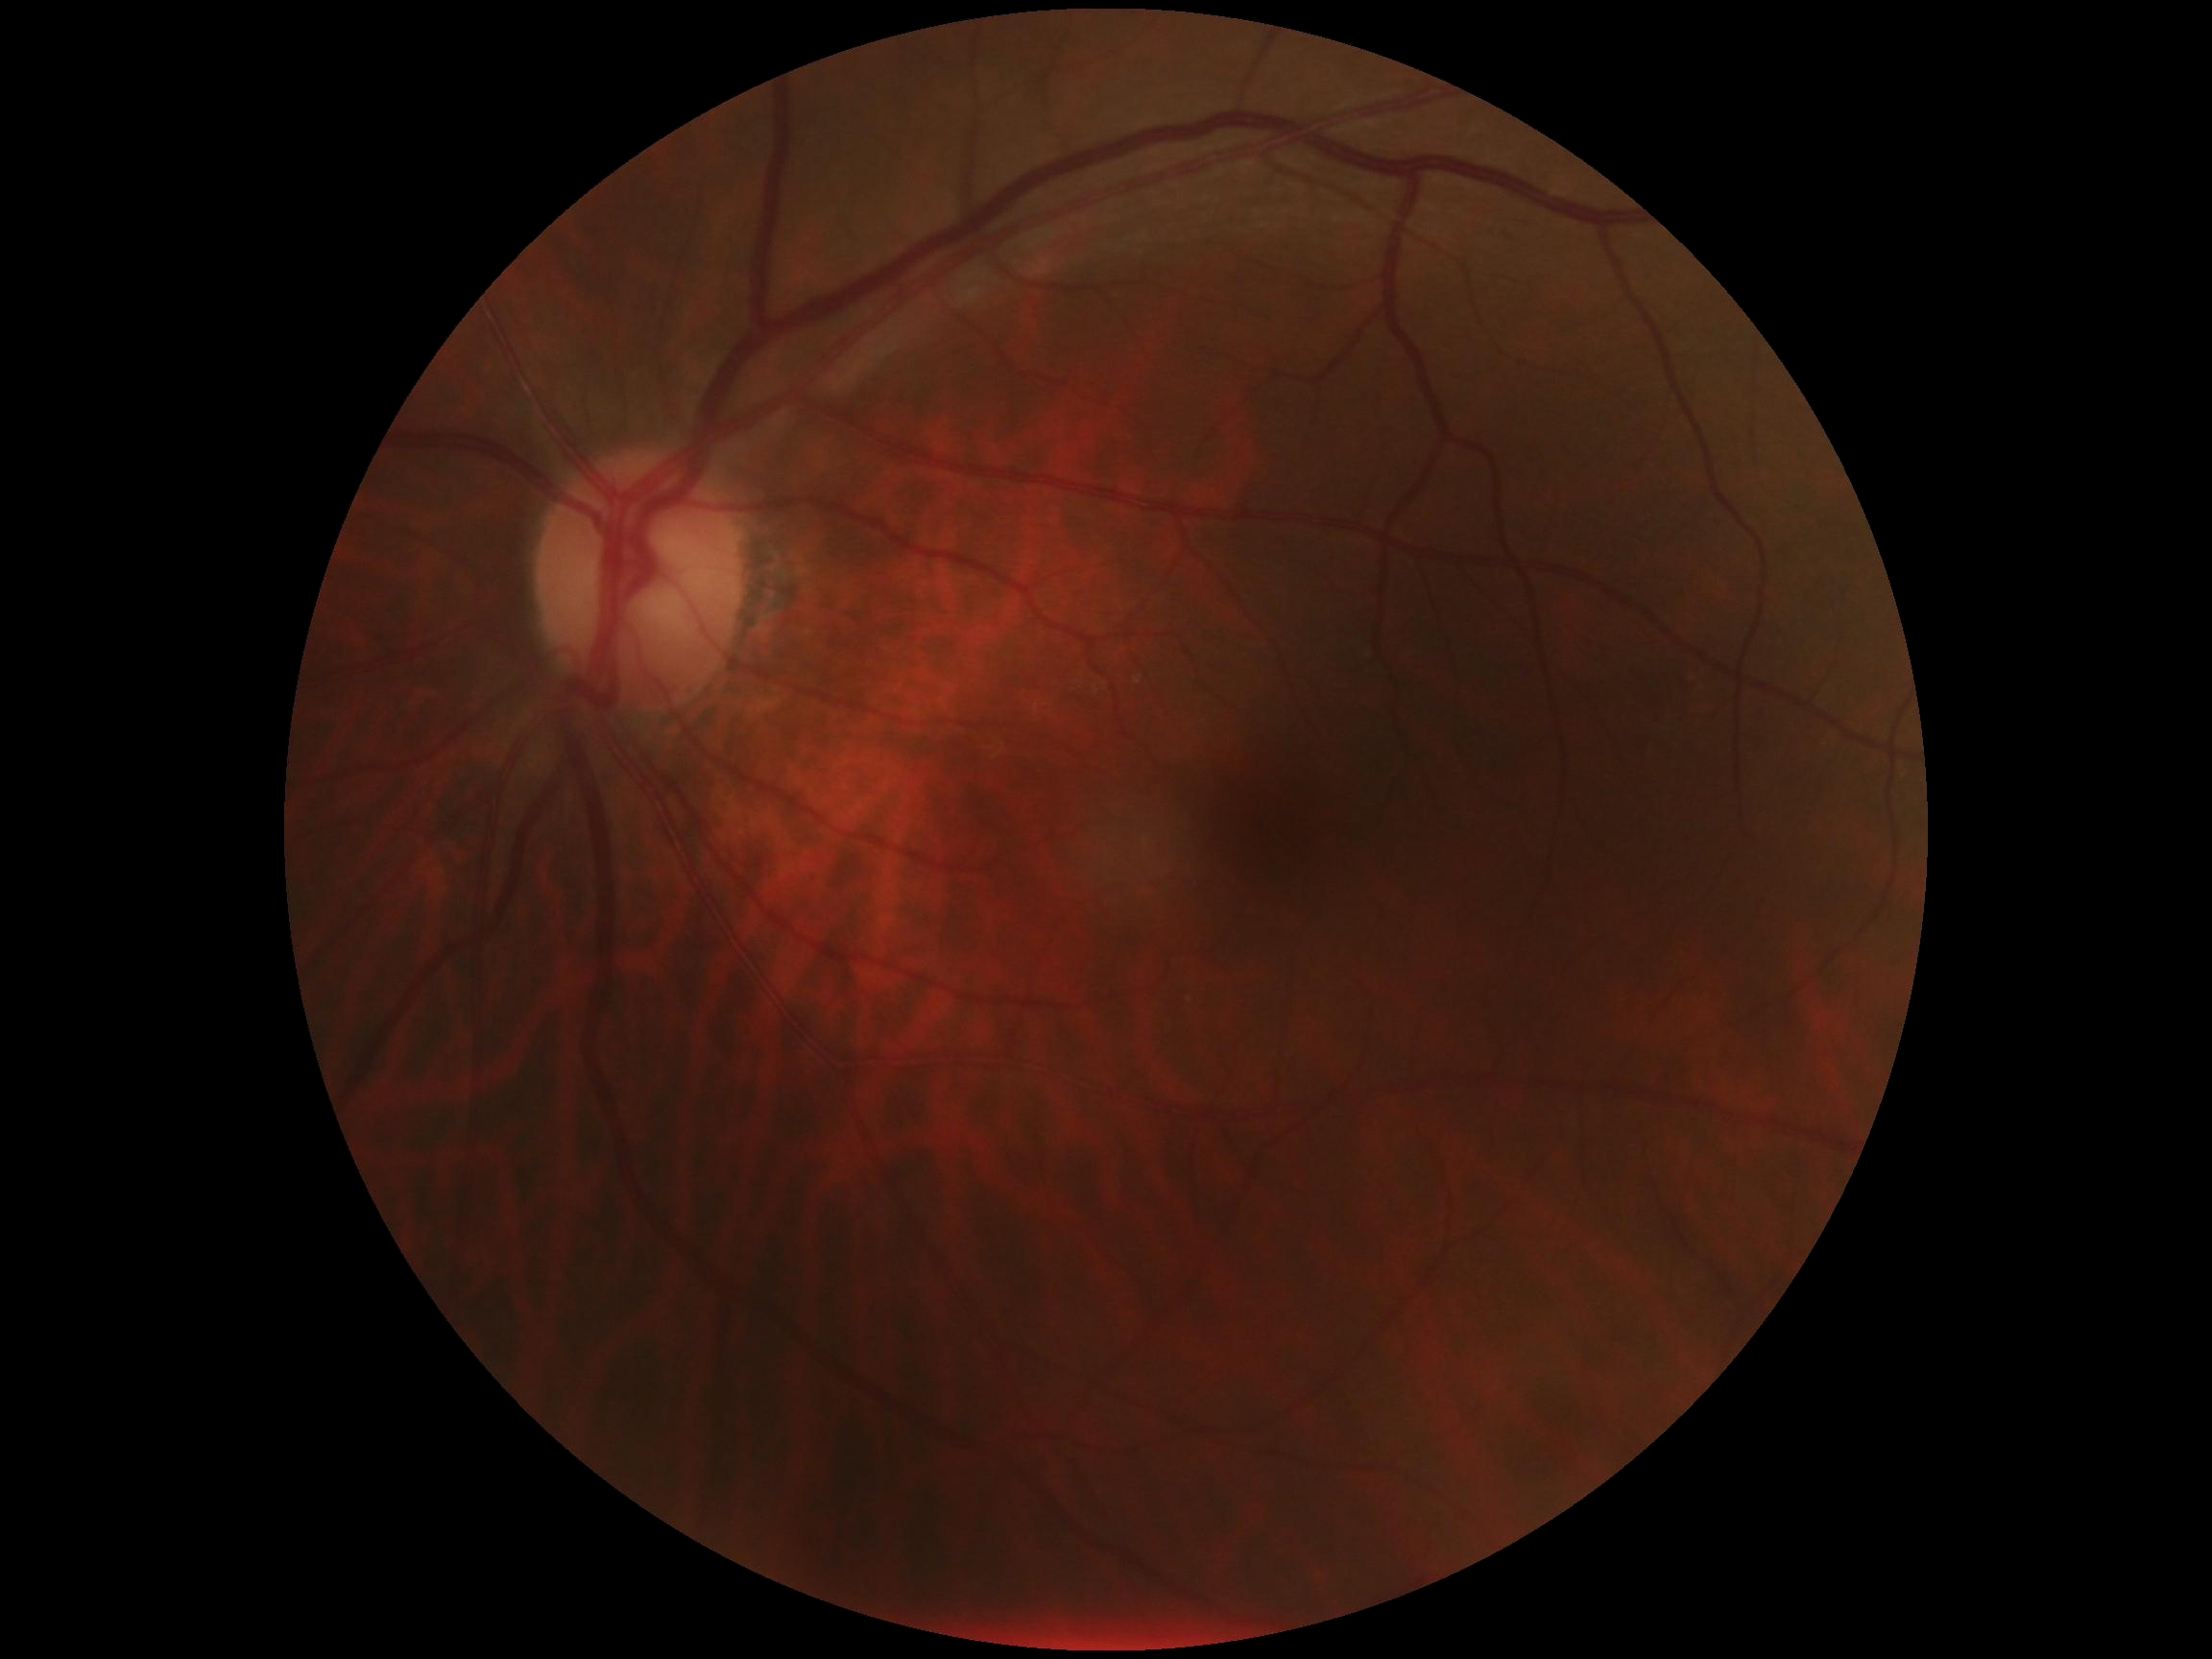 DR severity: 0/4.